45-degree field of view; image size 2048x1536; fundus photo — 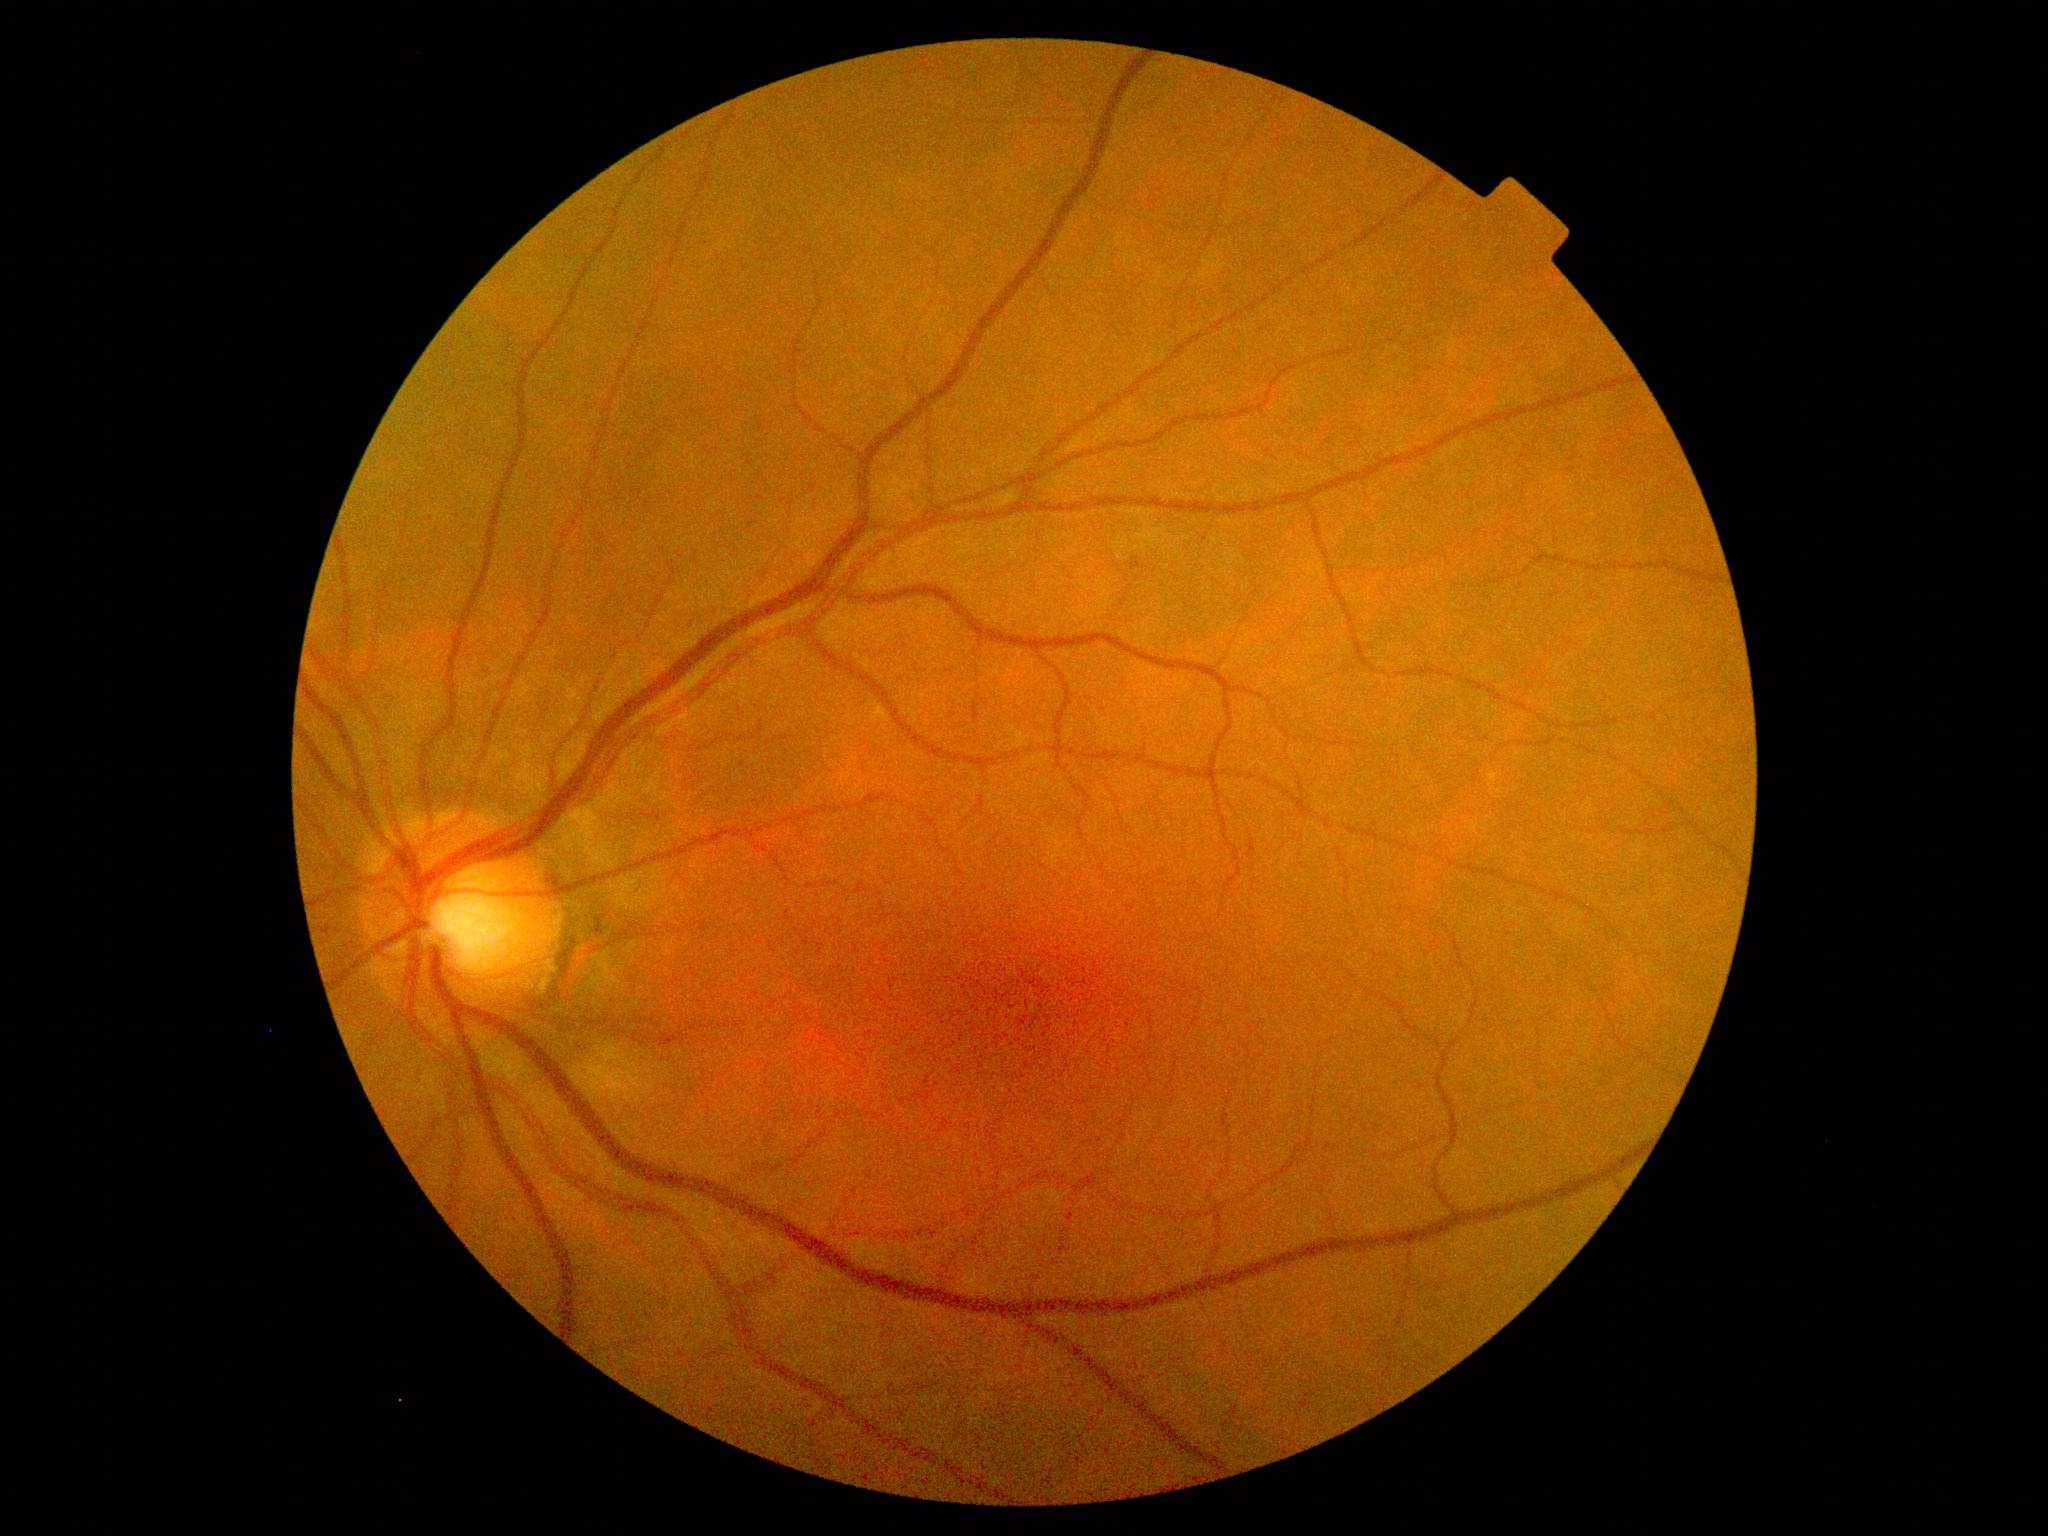

{"dr_grade": "grade 1", "dr_category": "non-proliferative diabetic retinopathy"}